Image size 2212x1659 — 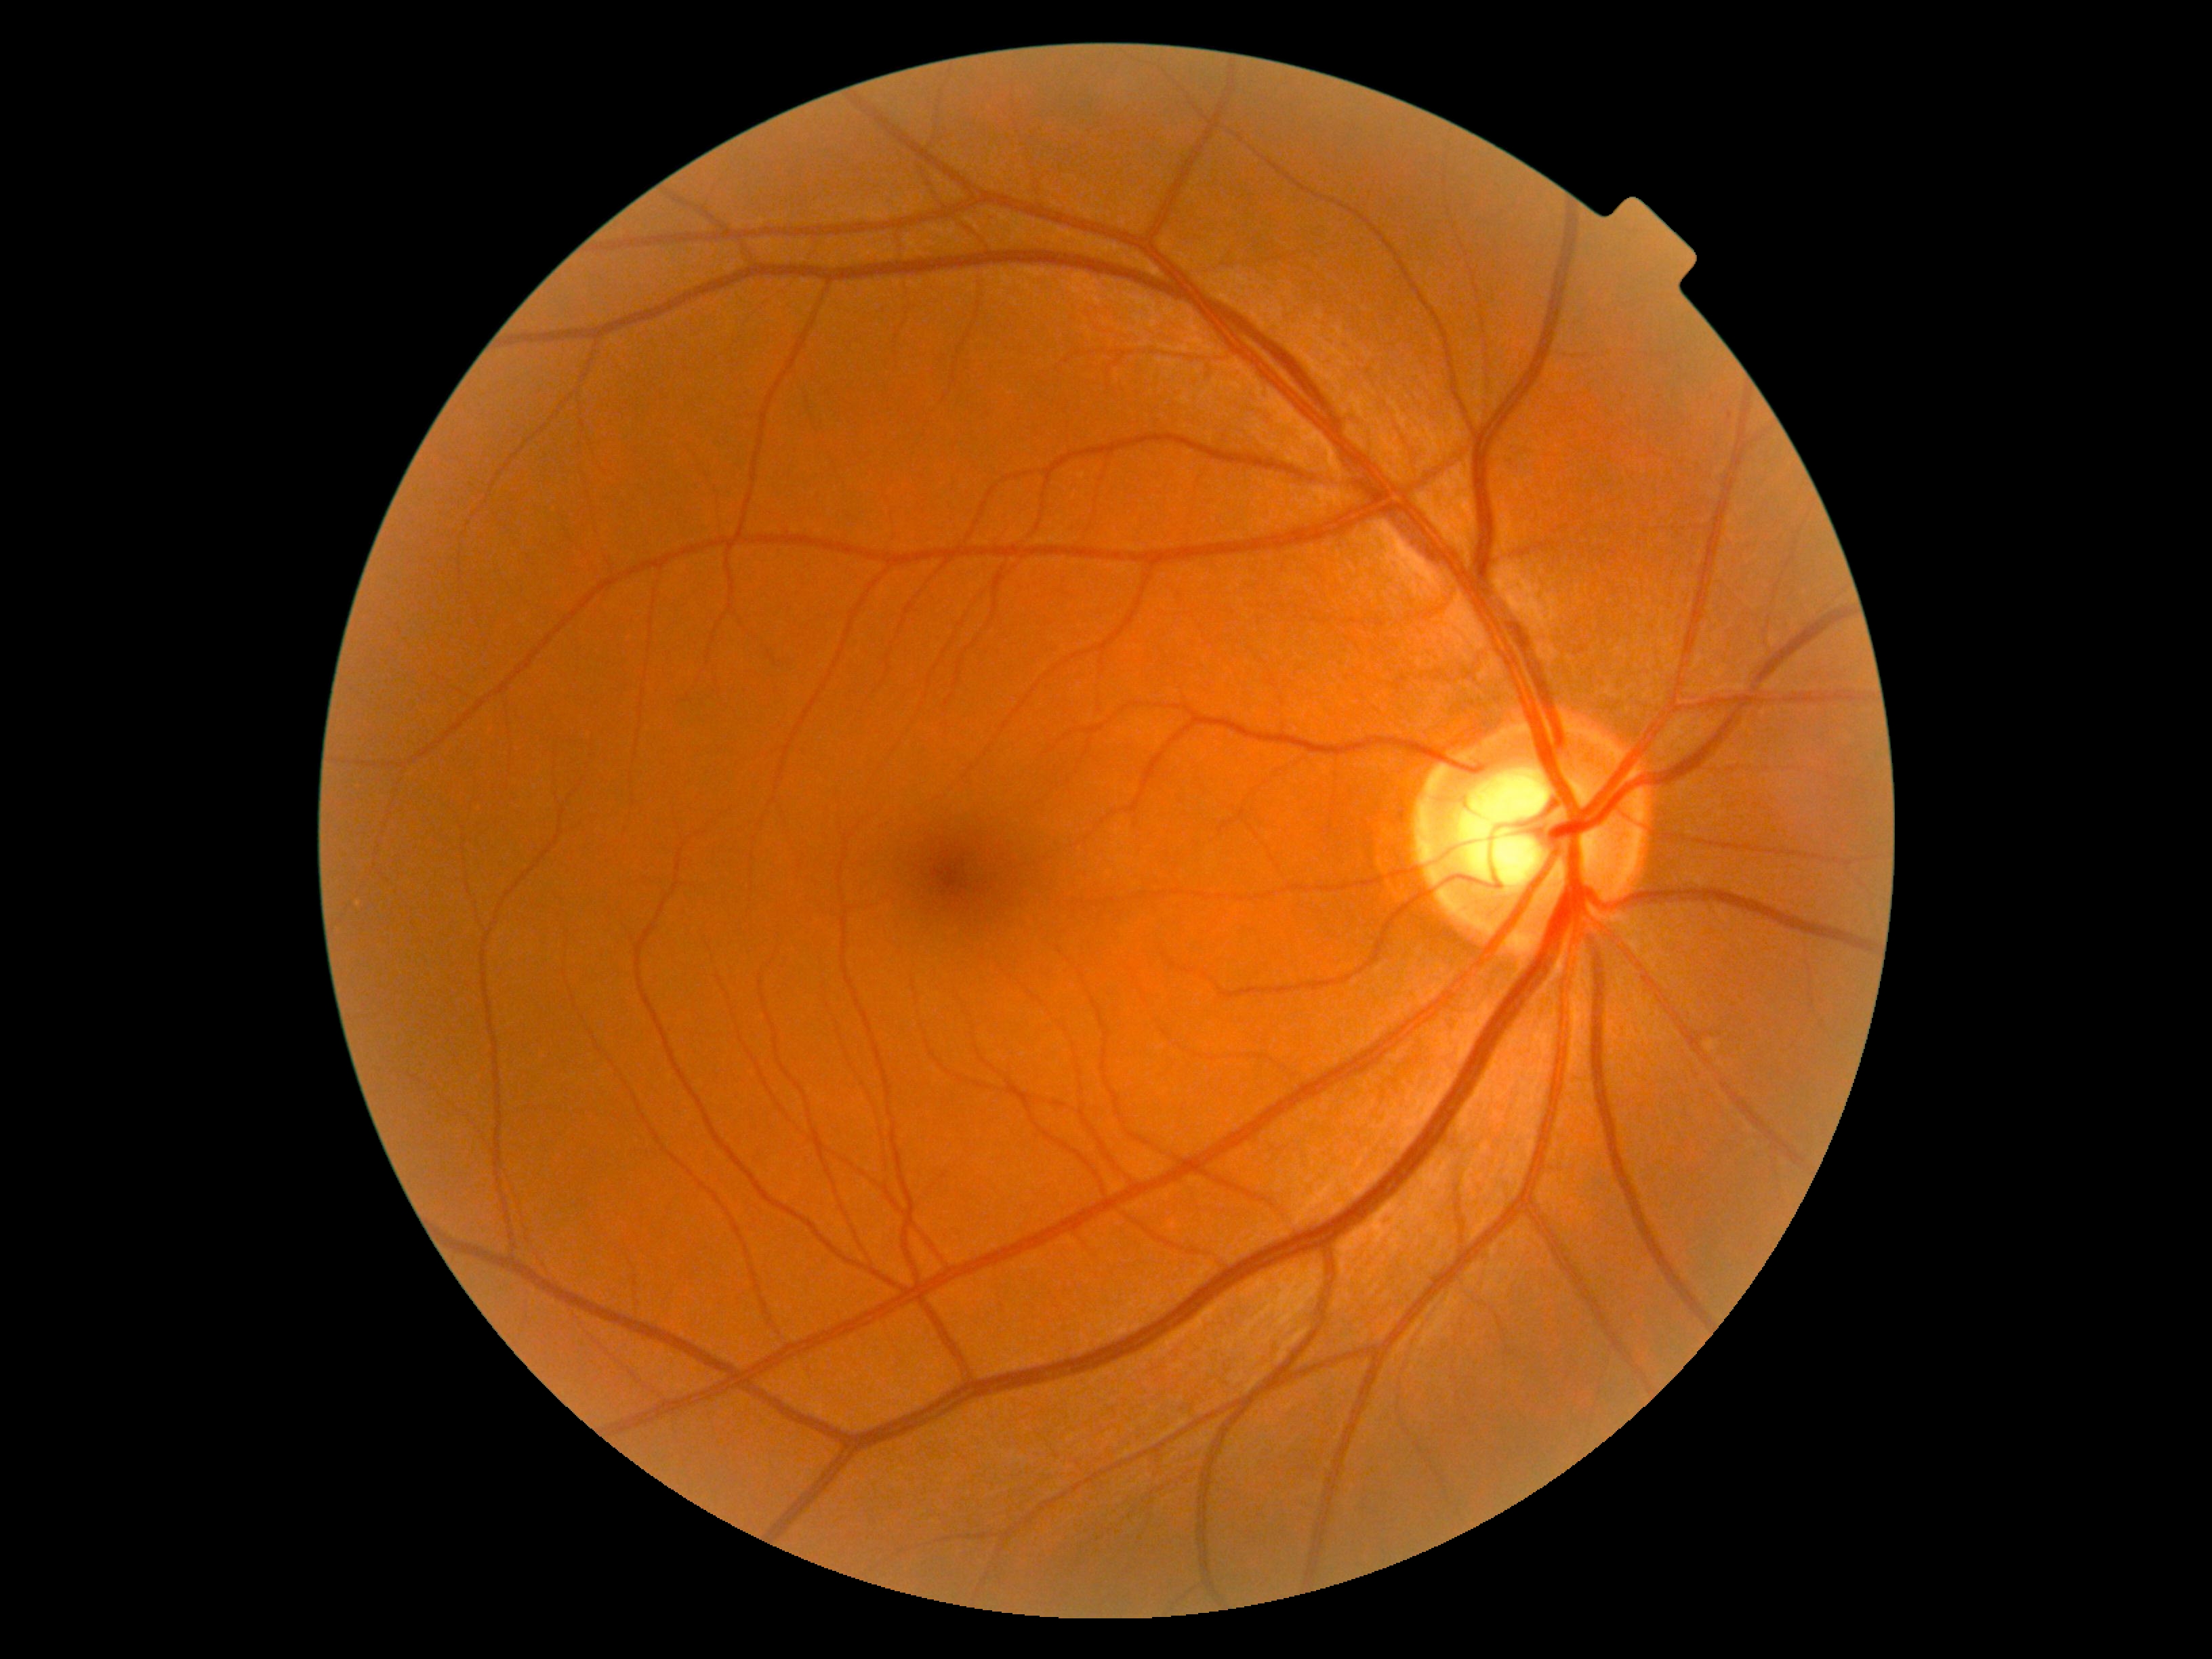
DR grade is 0/4.